45° FOV · retinal fundus photograph — 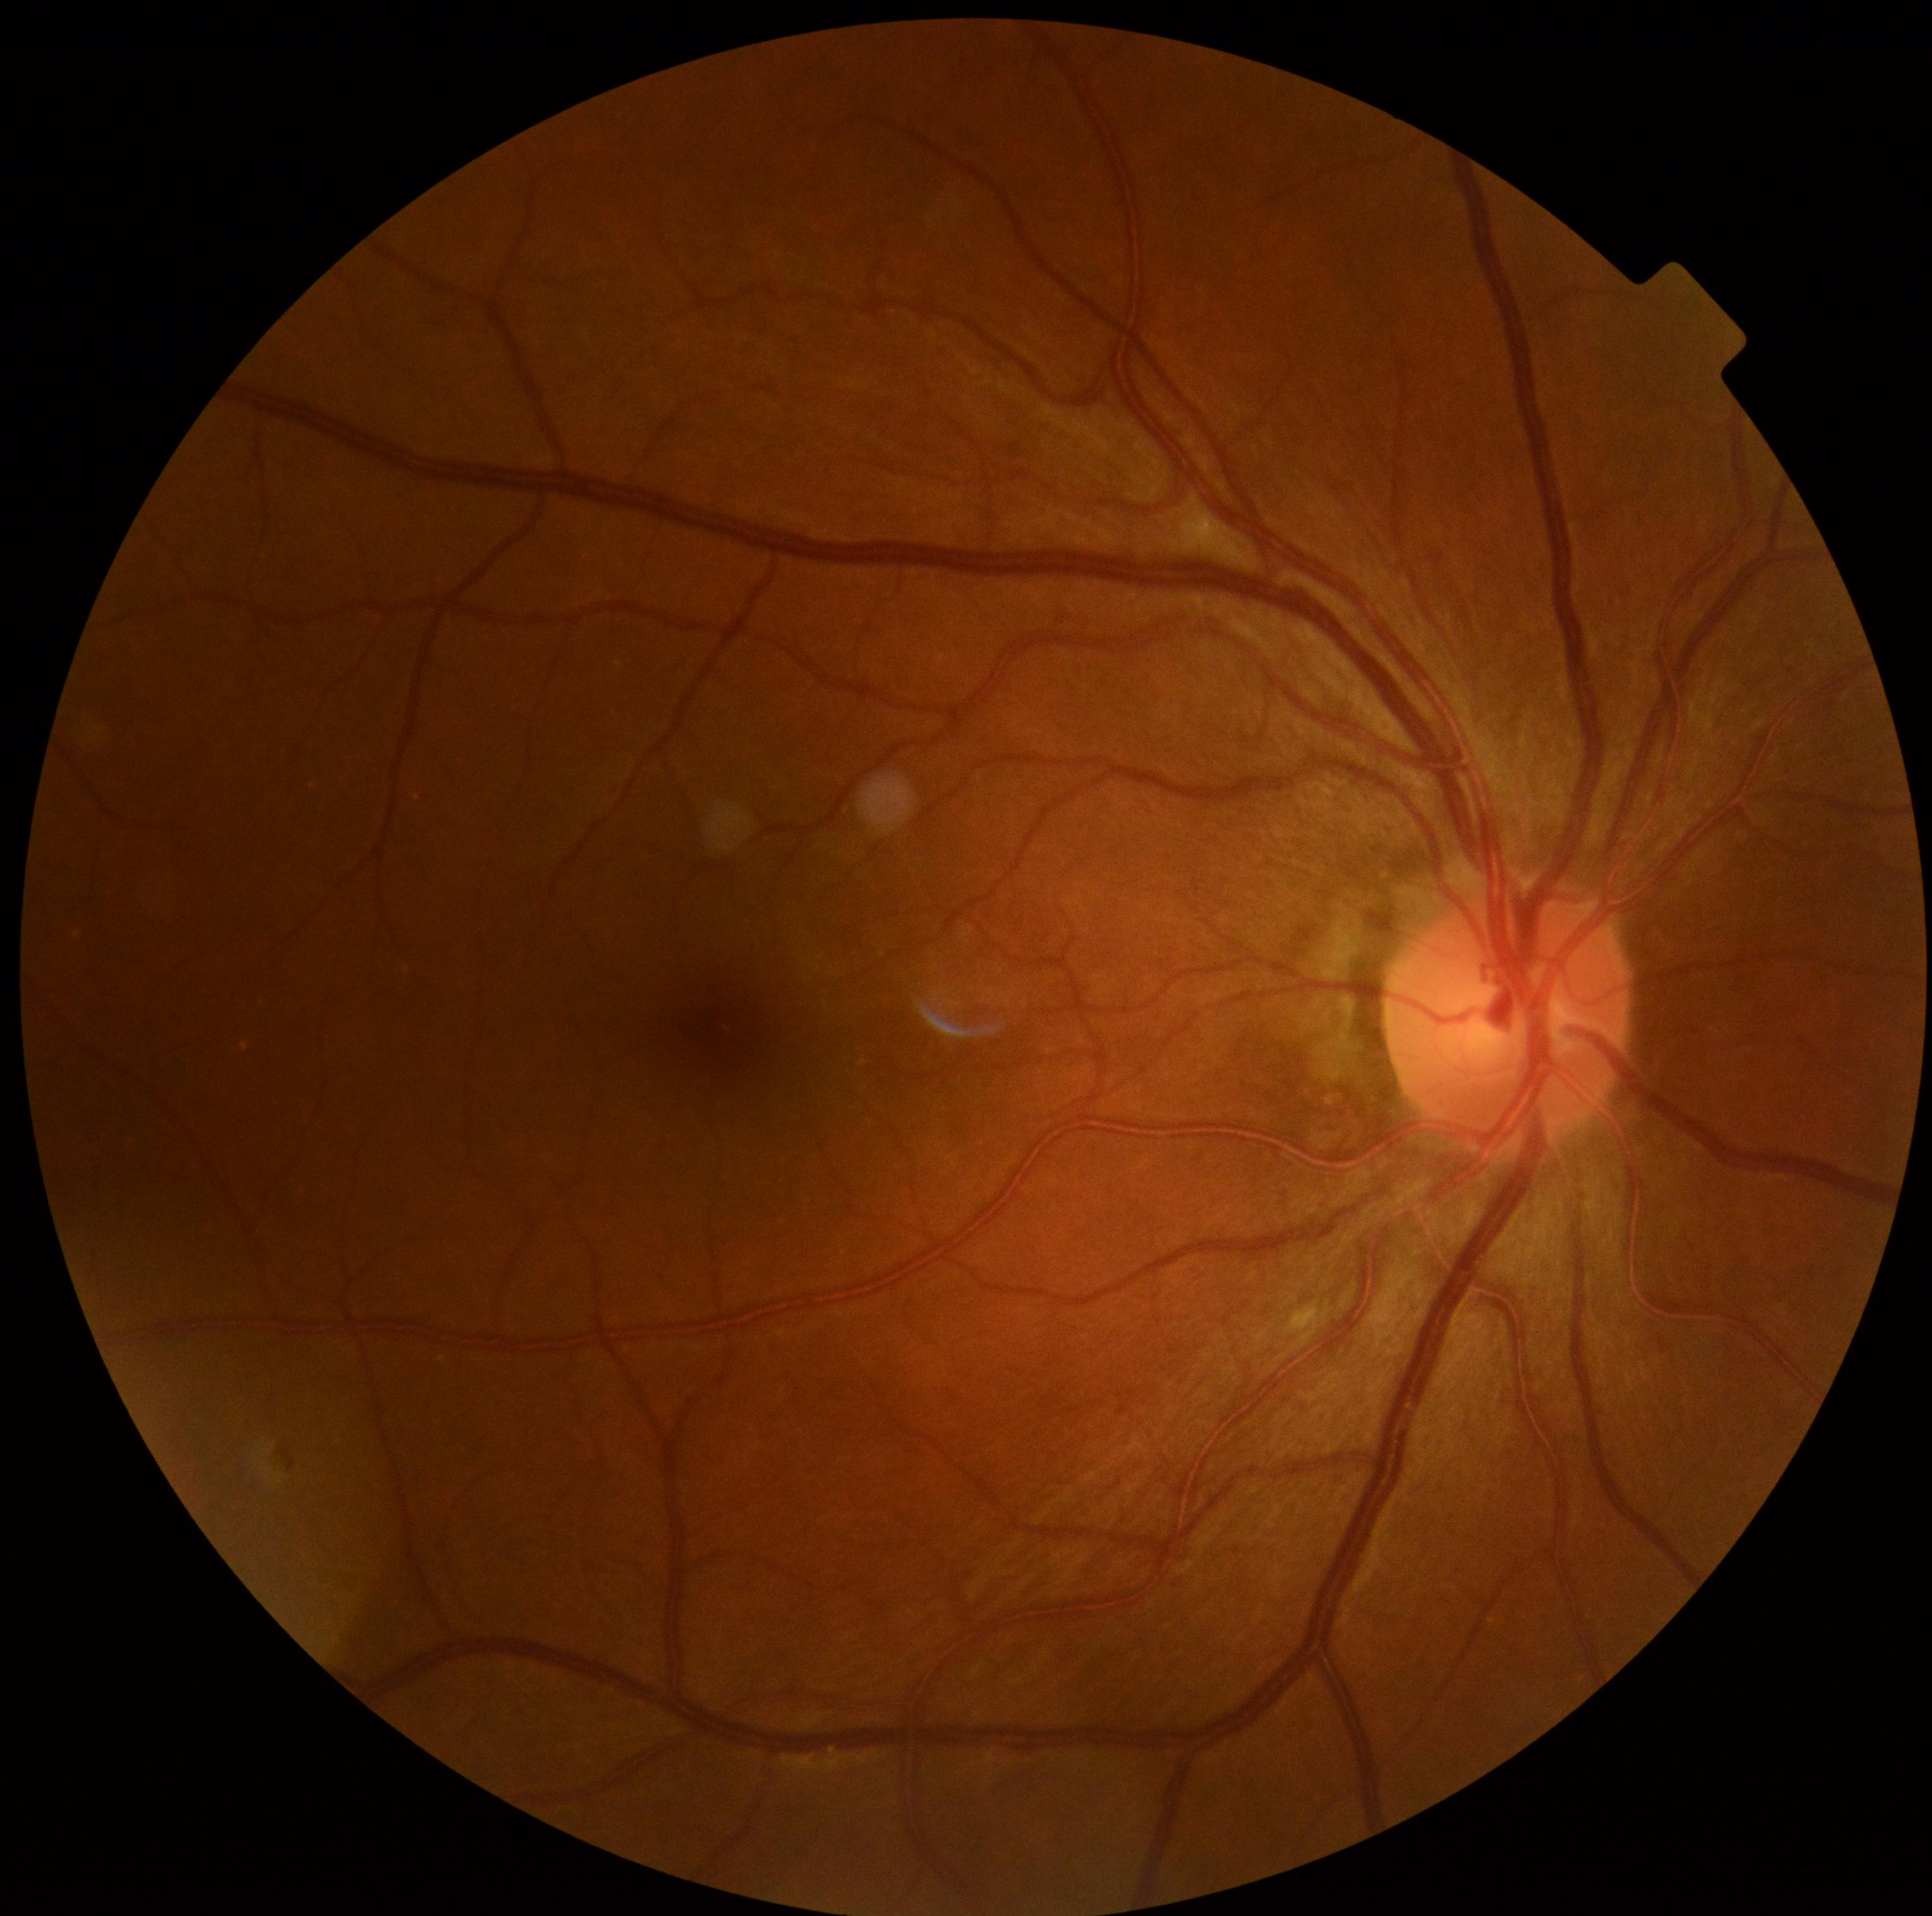

Findings:
- DR class: non-proliferative diabetic retinopathy
- DR severity: 2/4